45° FOV · 2352x1568
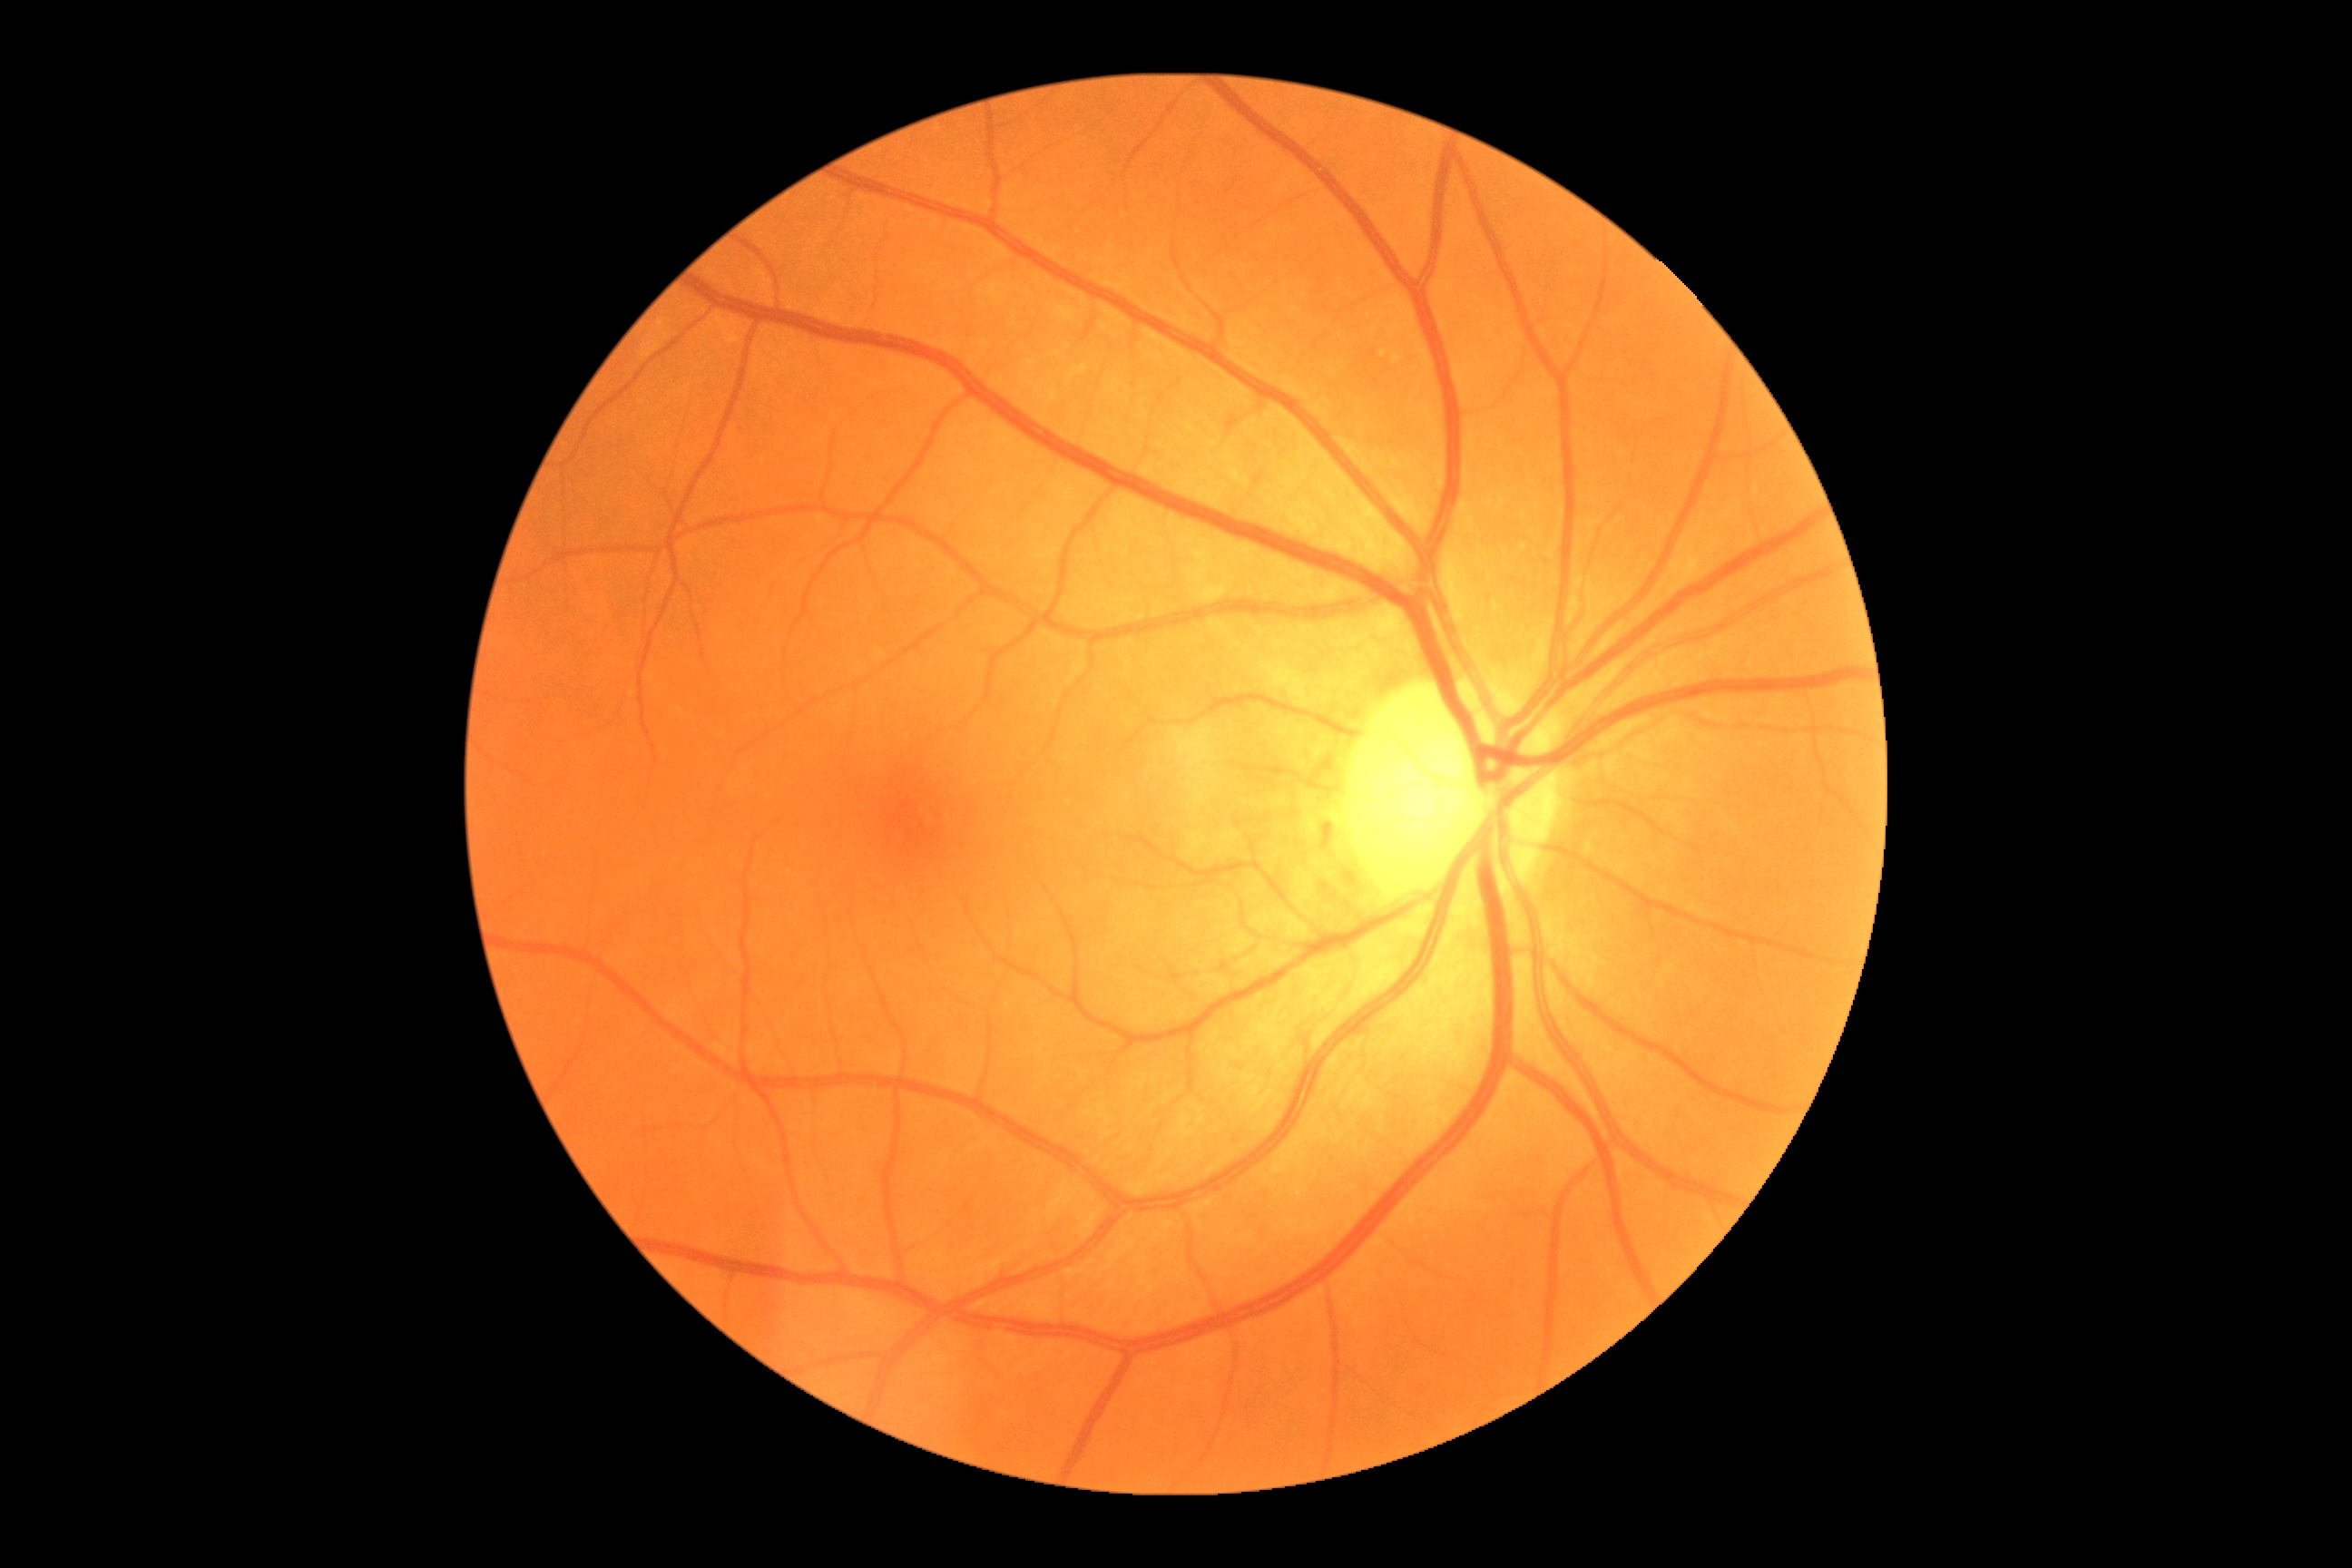

DR is no apparent retinopathy (grade 0) — no visible signs of diabetic retinopathy.